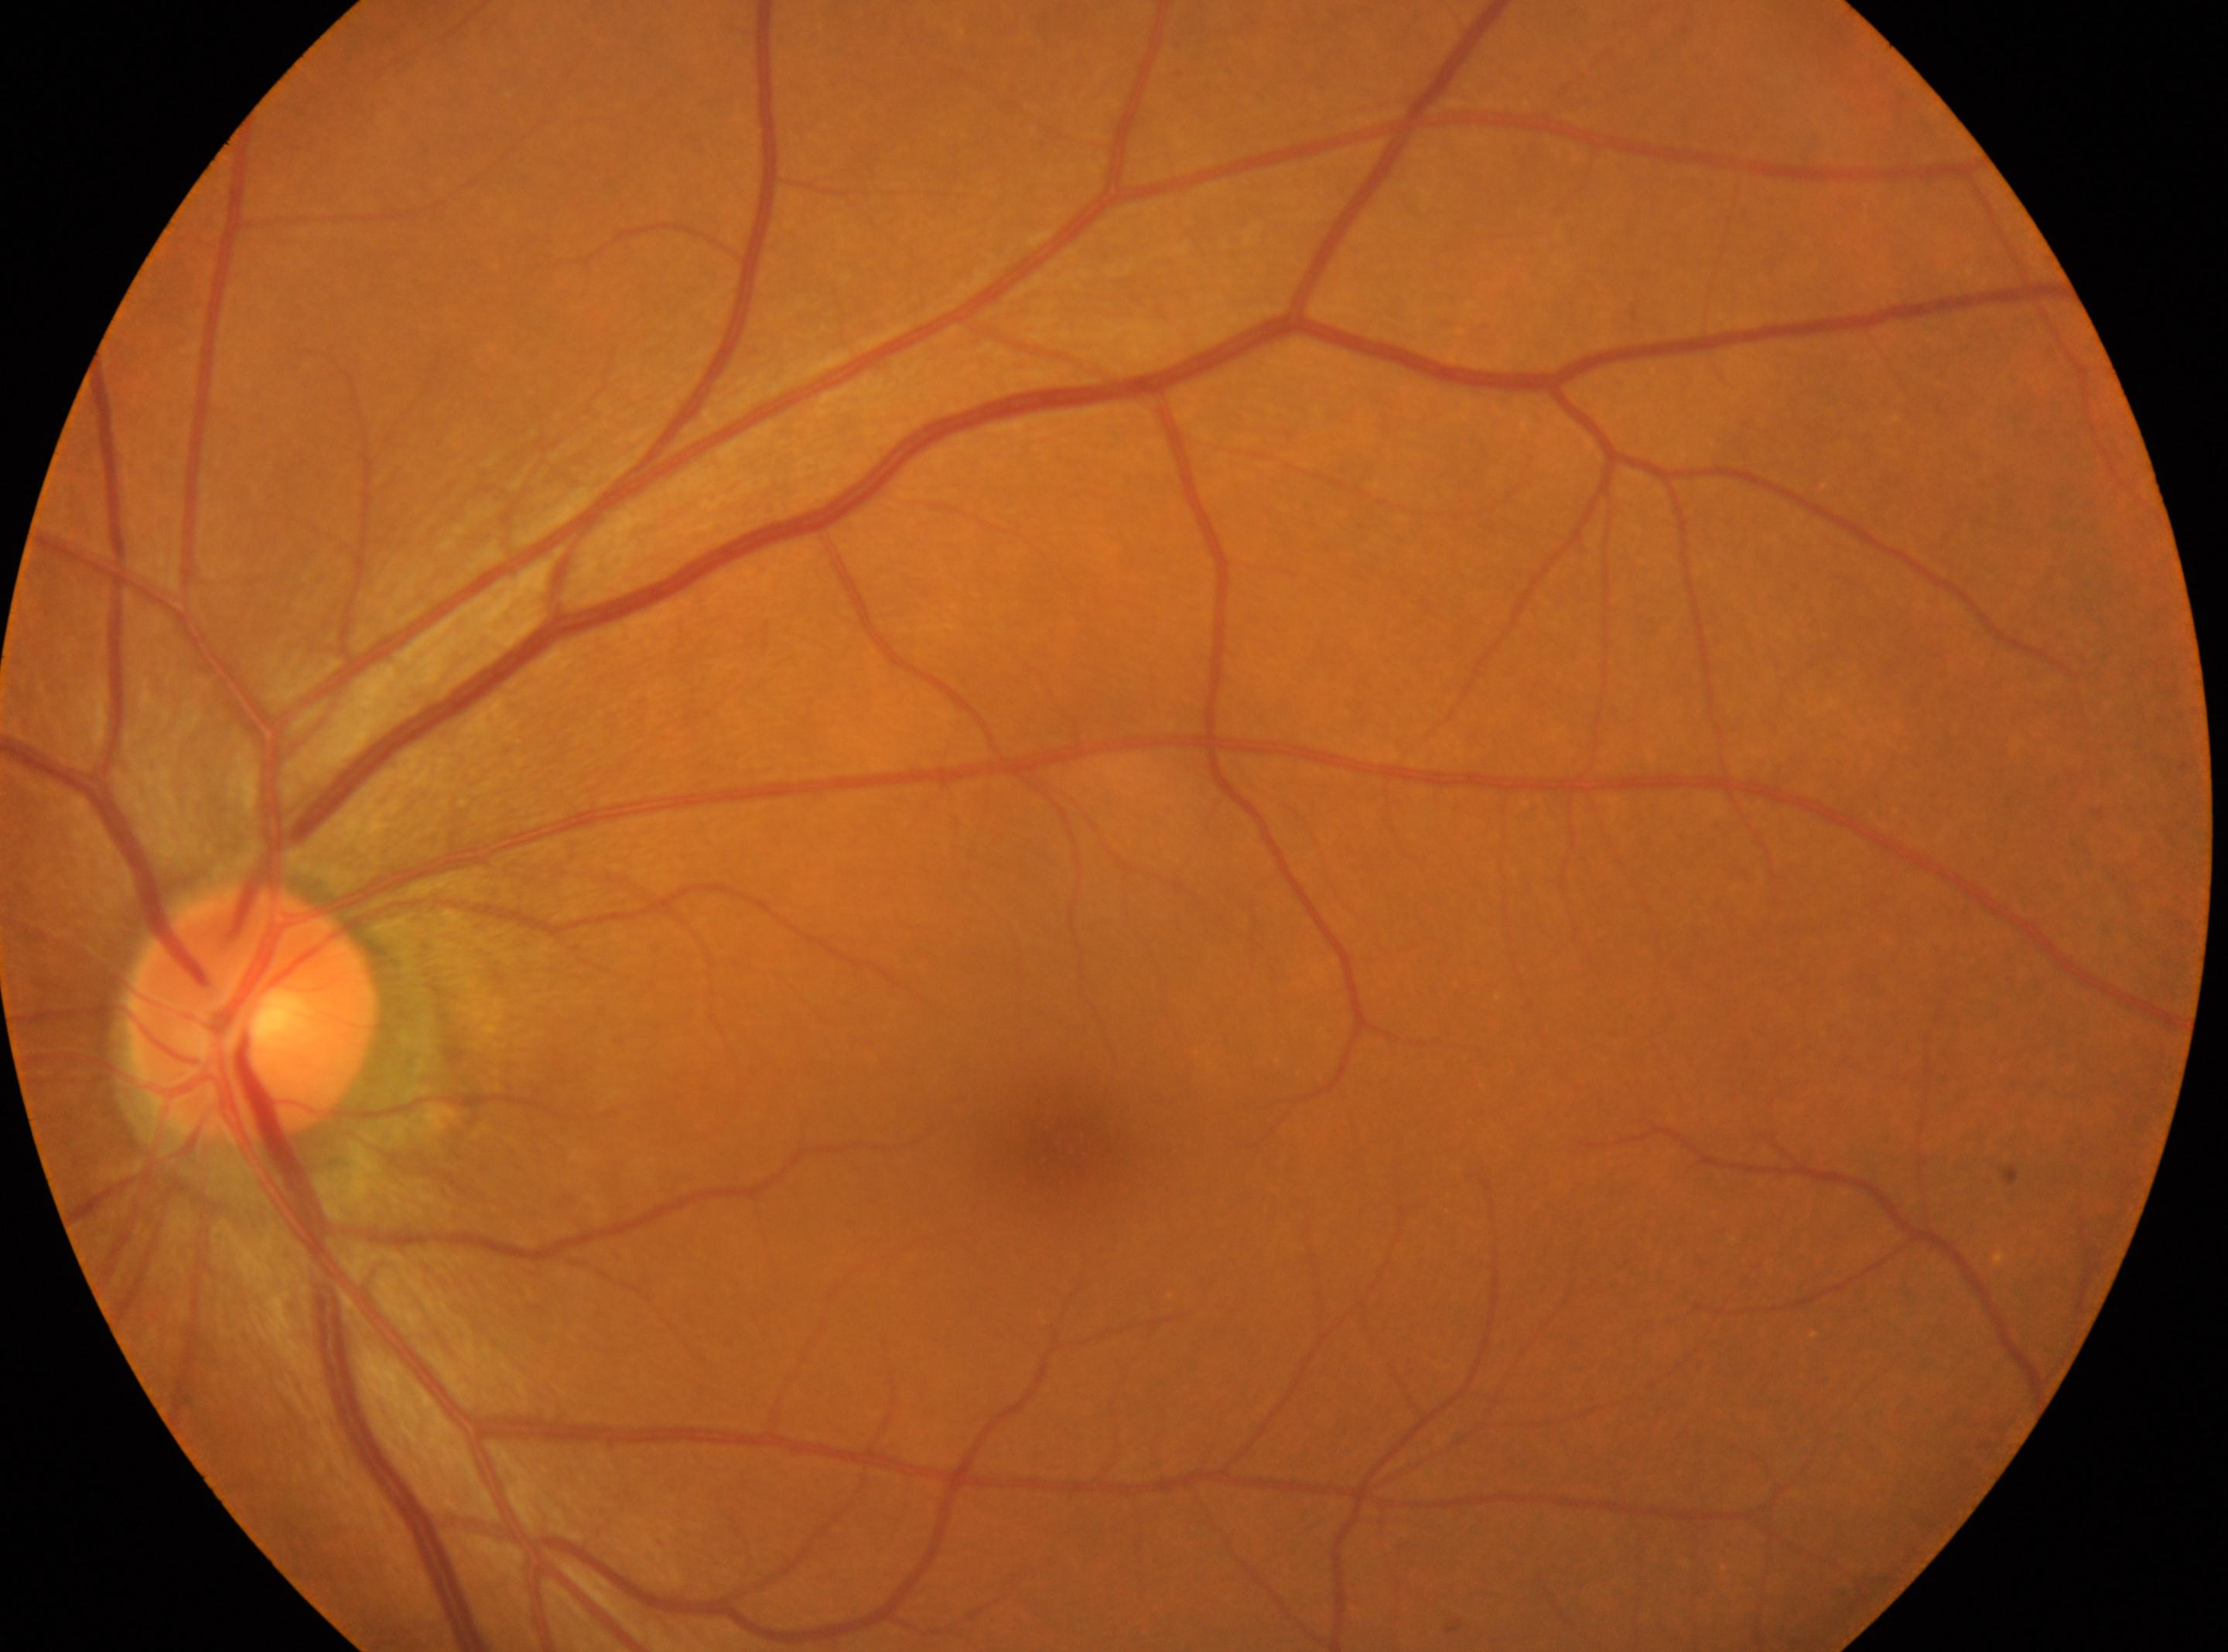
The optic nerve head is at x=254, y=1013. Diabetic retinopathy (DR): grade 0. The image shows the OS. The fovea centralis is at x=1068, y=1140.